Davis DR grading.
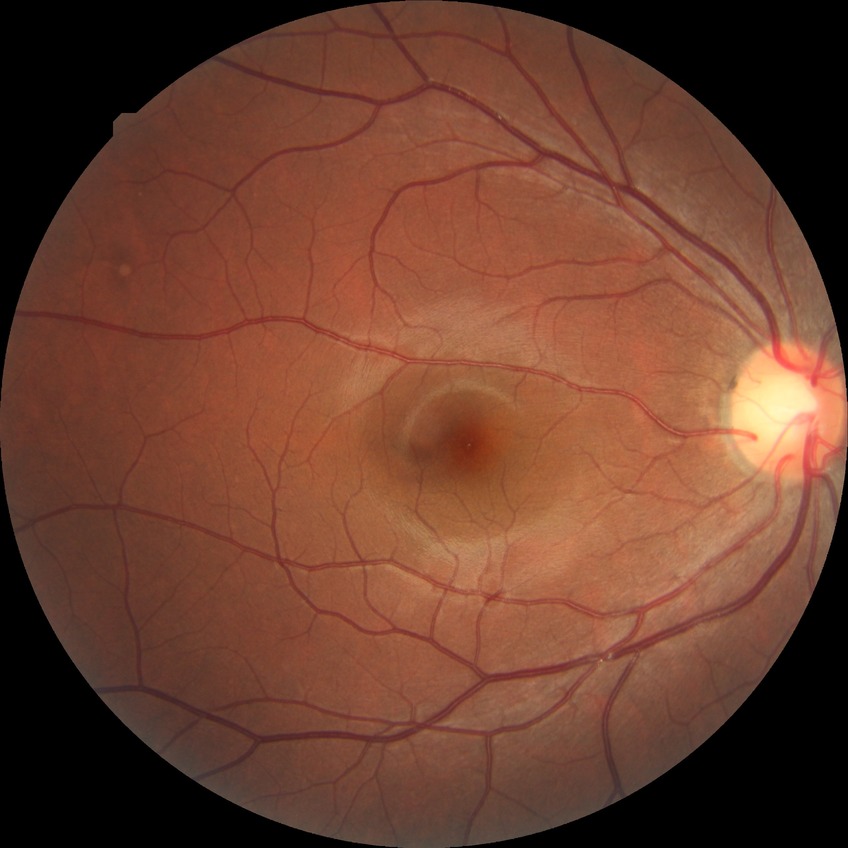

Diabetic retinopathy (DR) is no diabetic retinopathy (NDR).